Color fundus photograph, 45° FOV, 1932 by 1910 pixels:
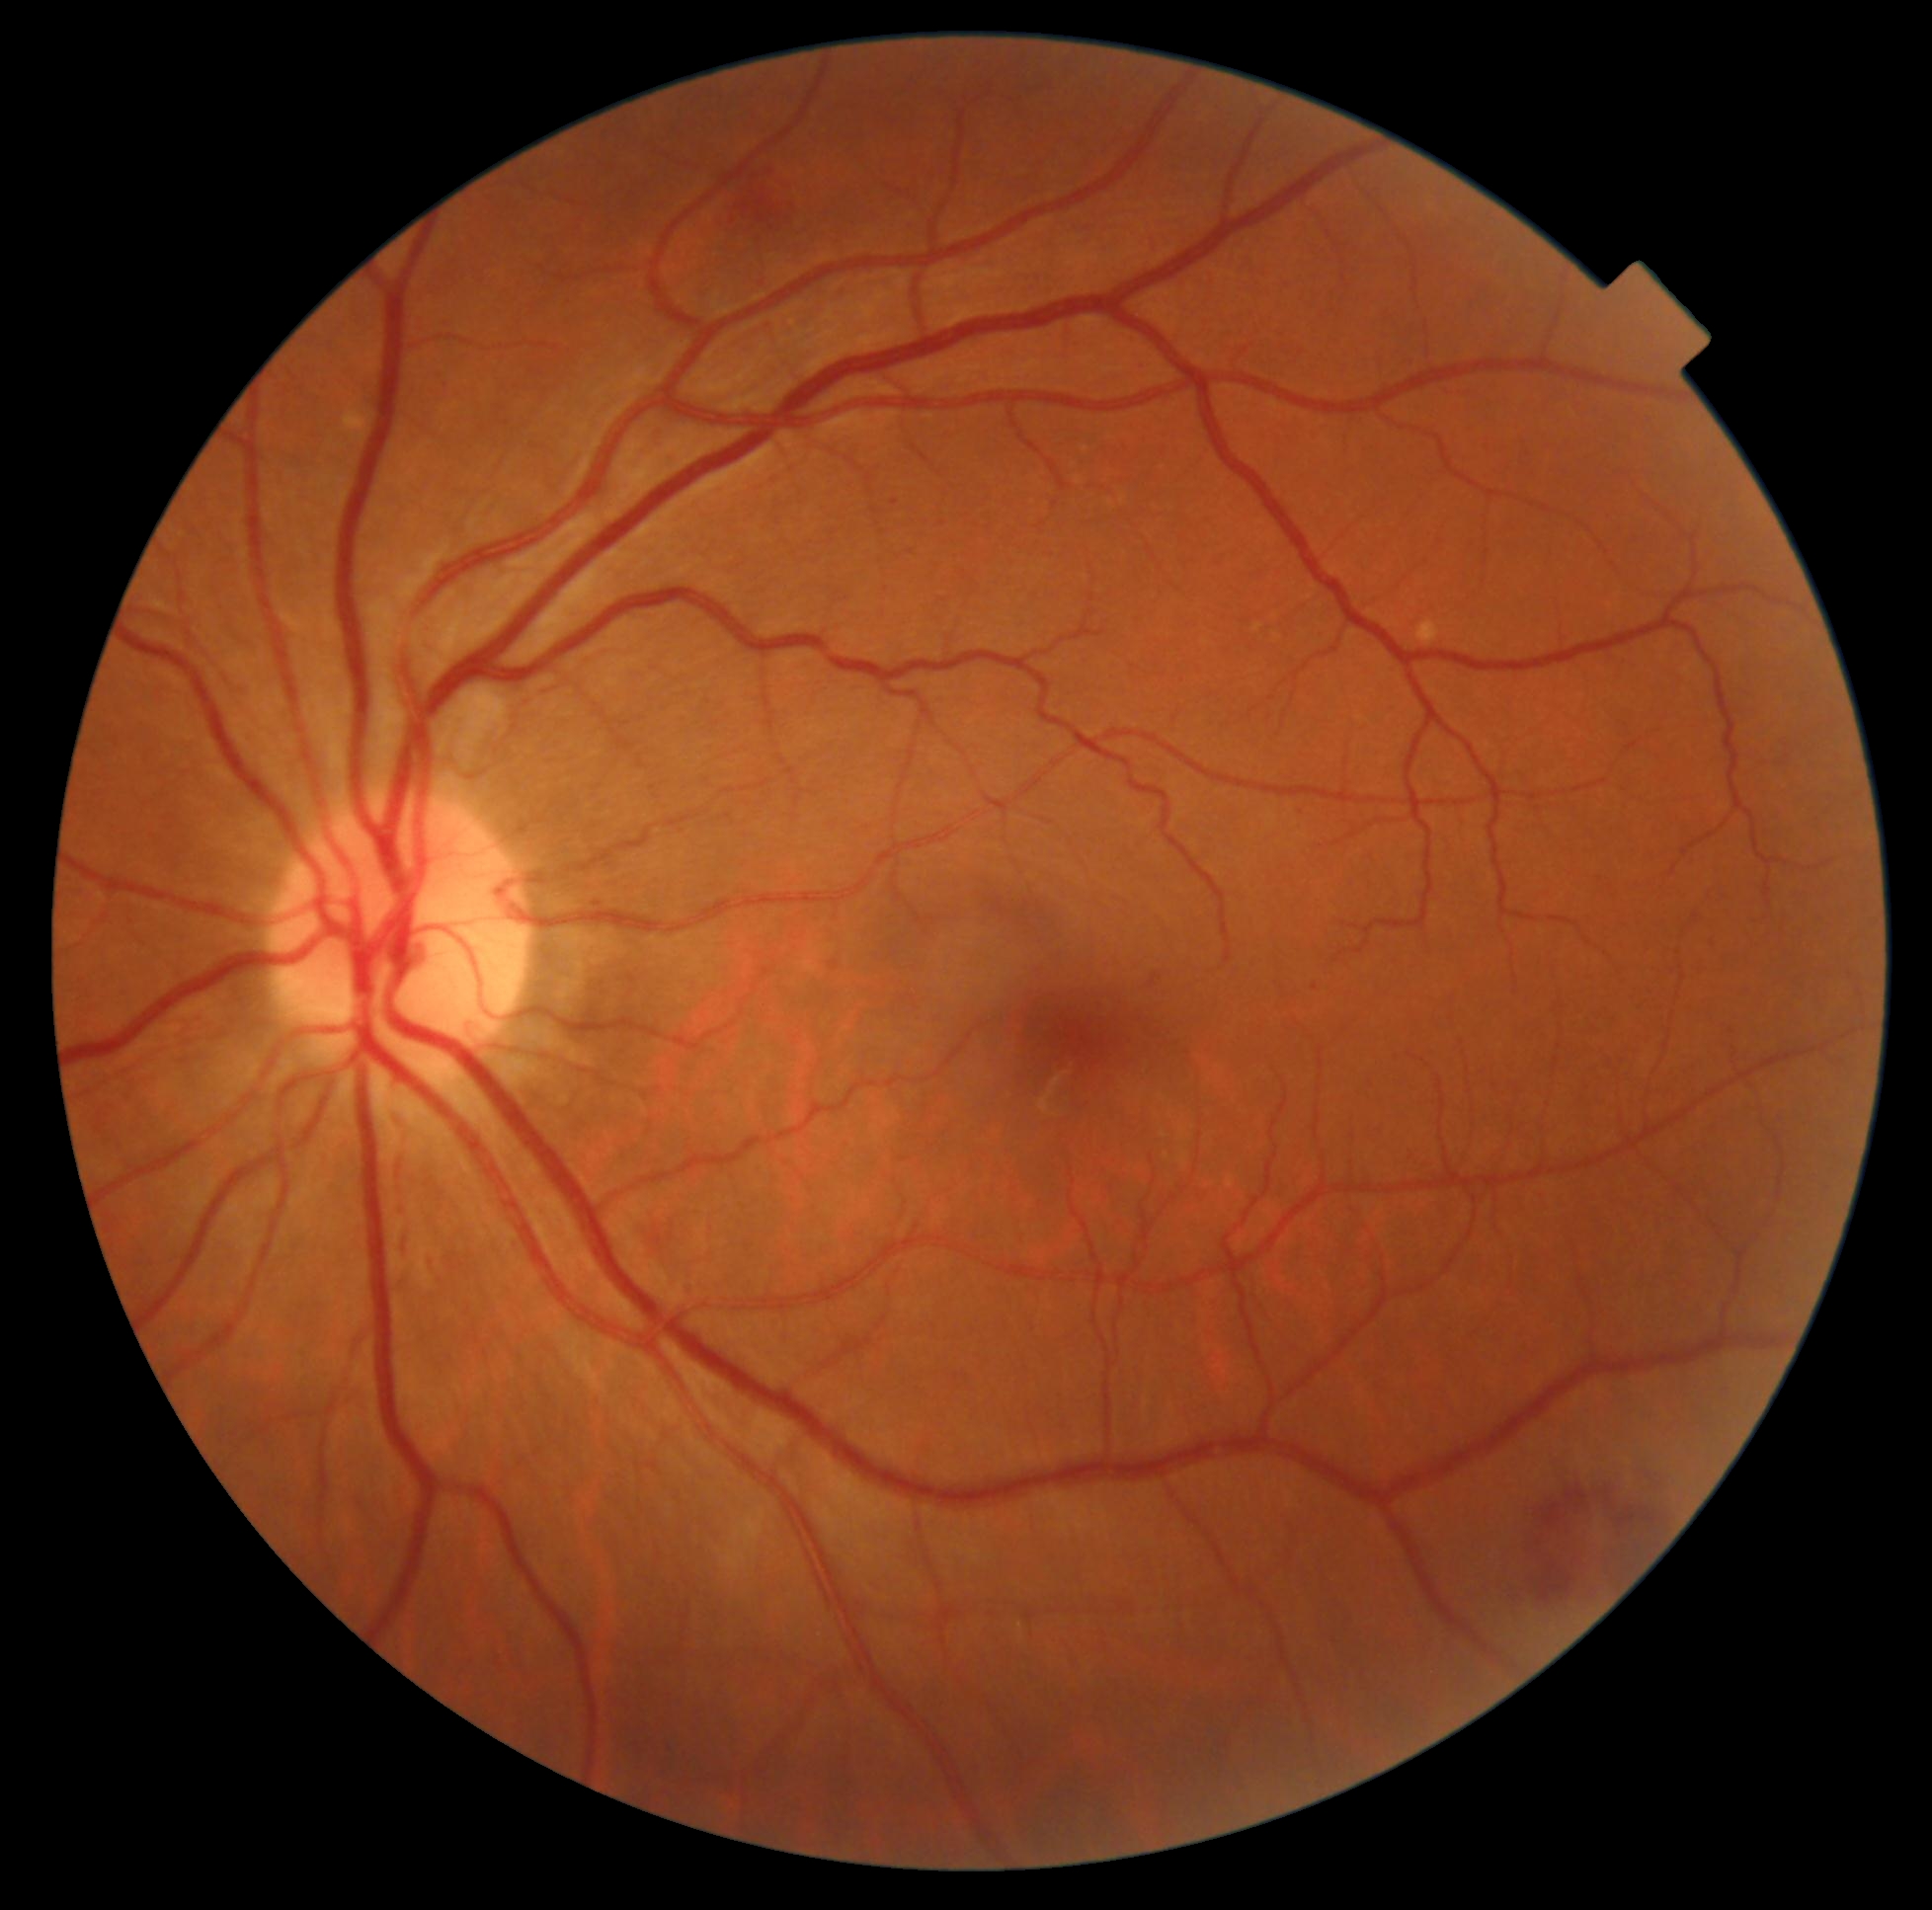 diabetic retinopathy severity=moderate NPDR (grade 2).